NIDEK AFC-230 fundus camera. 45-degree field of view. Posterior pole color fundus photograph — 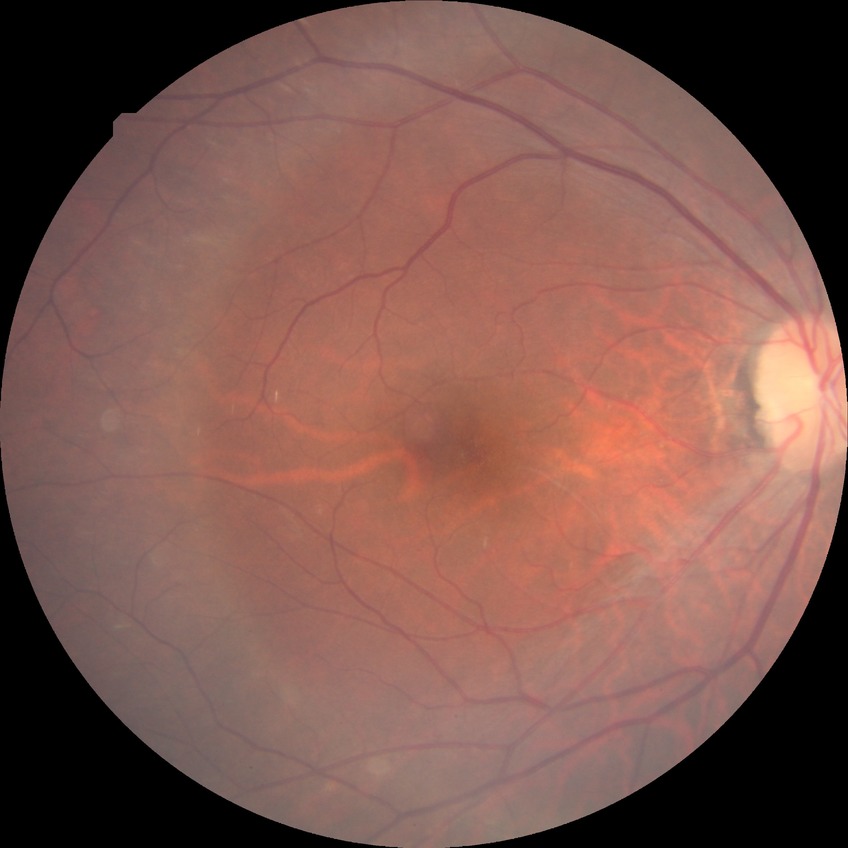 Annotations:
• diabetic retinopathy (DR): no diabetic retinopathy (NDR)